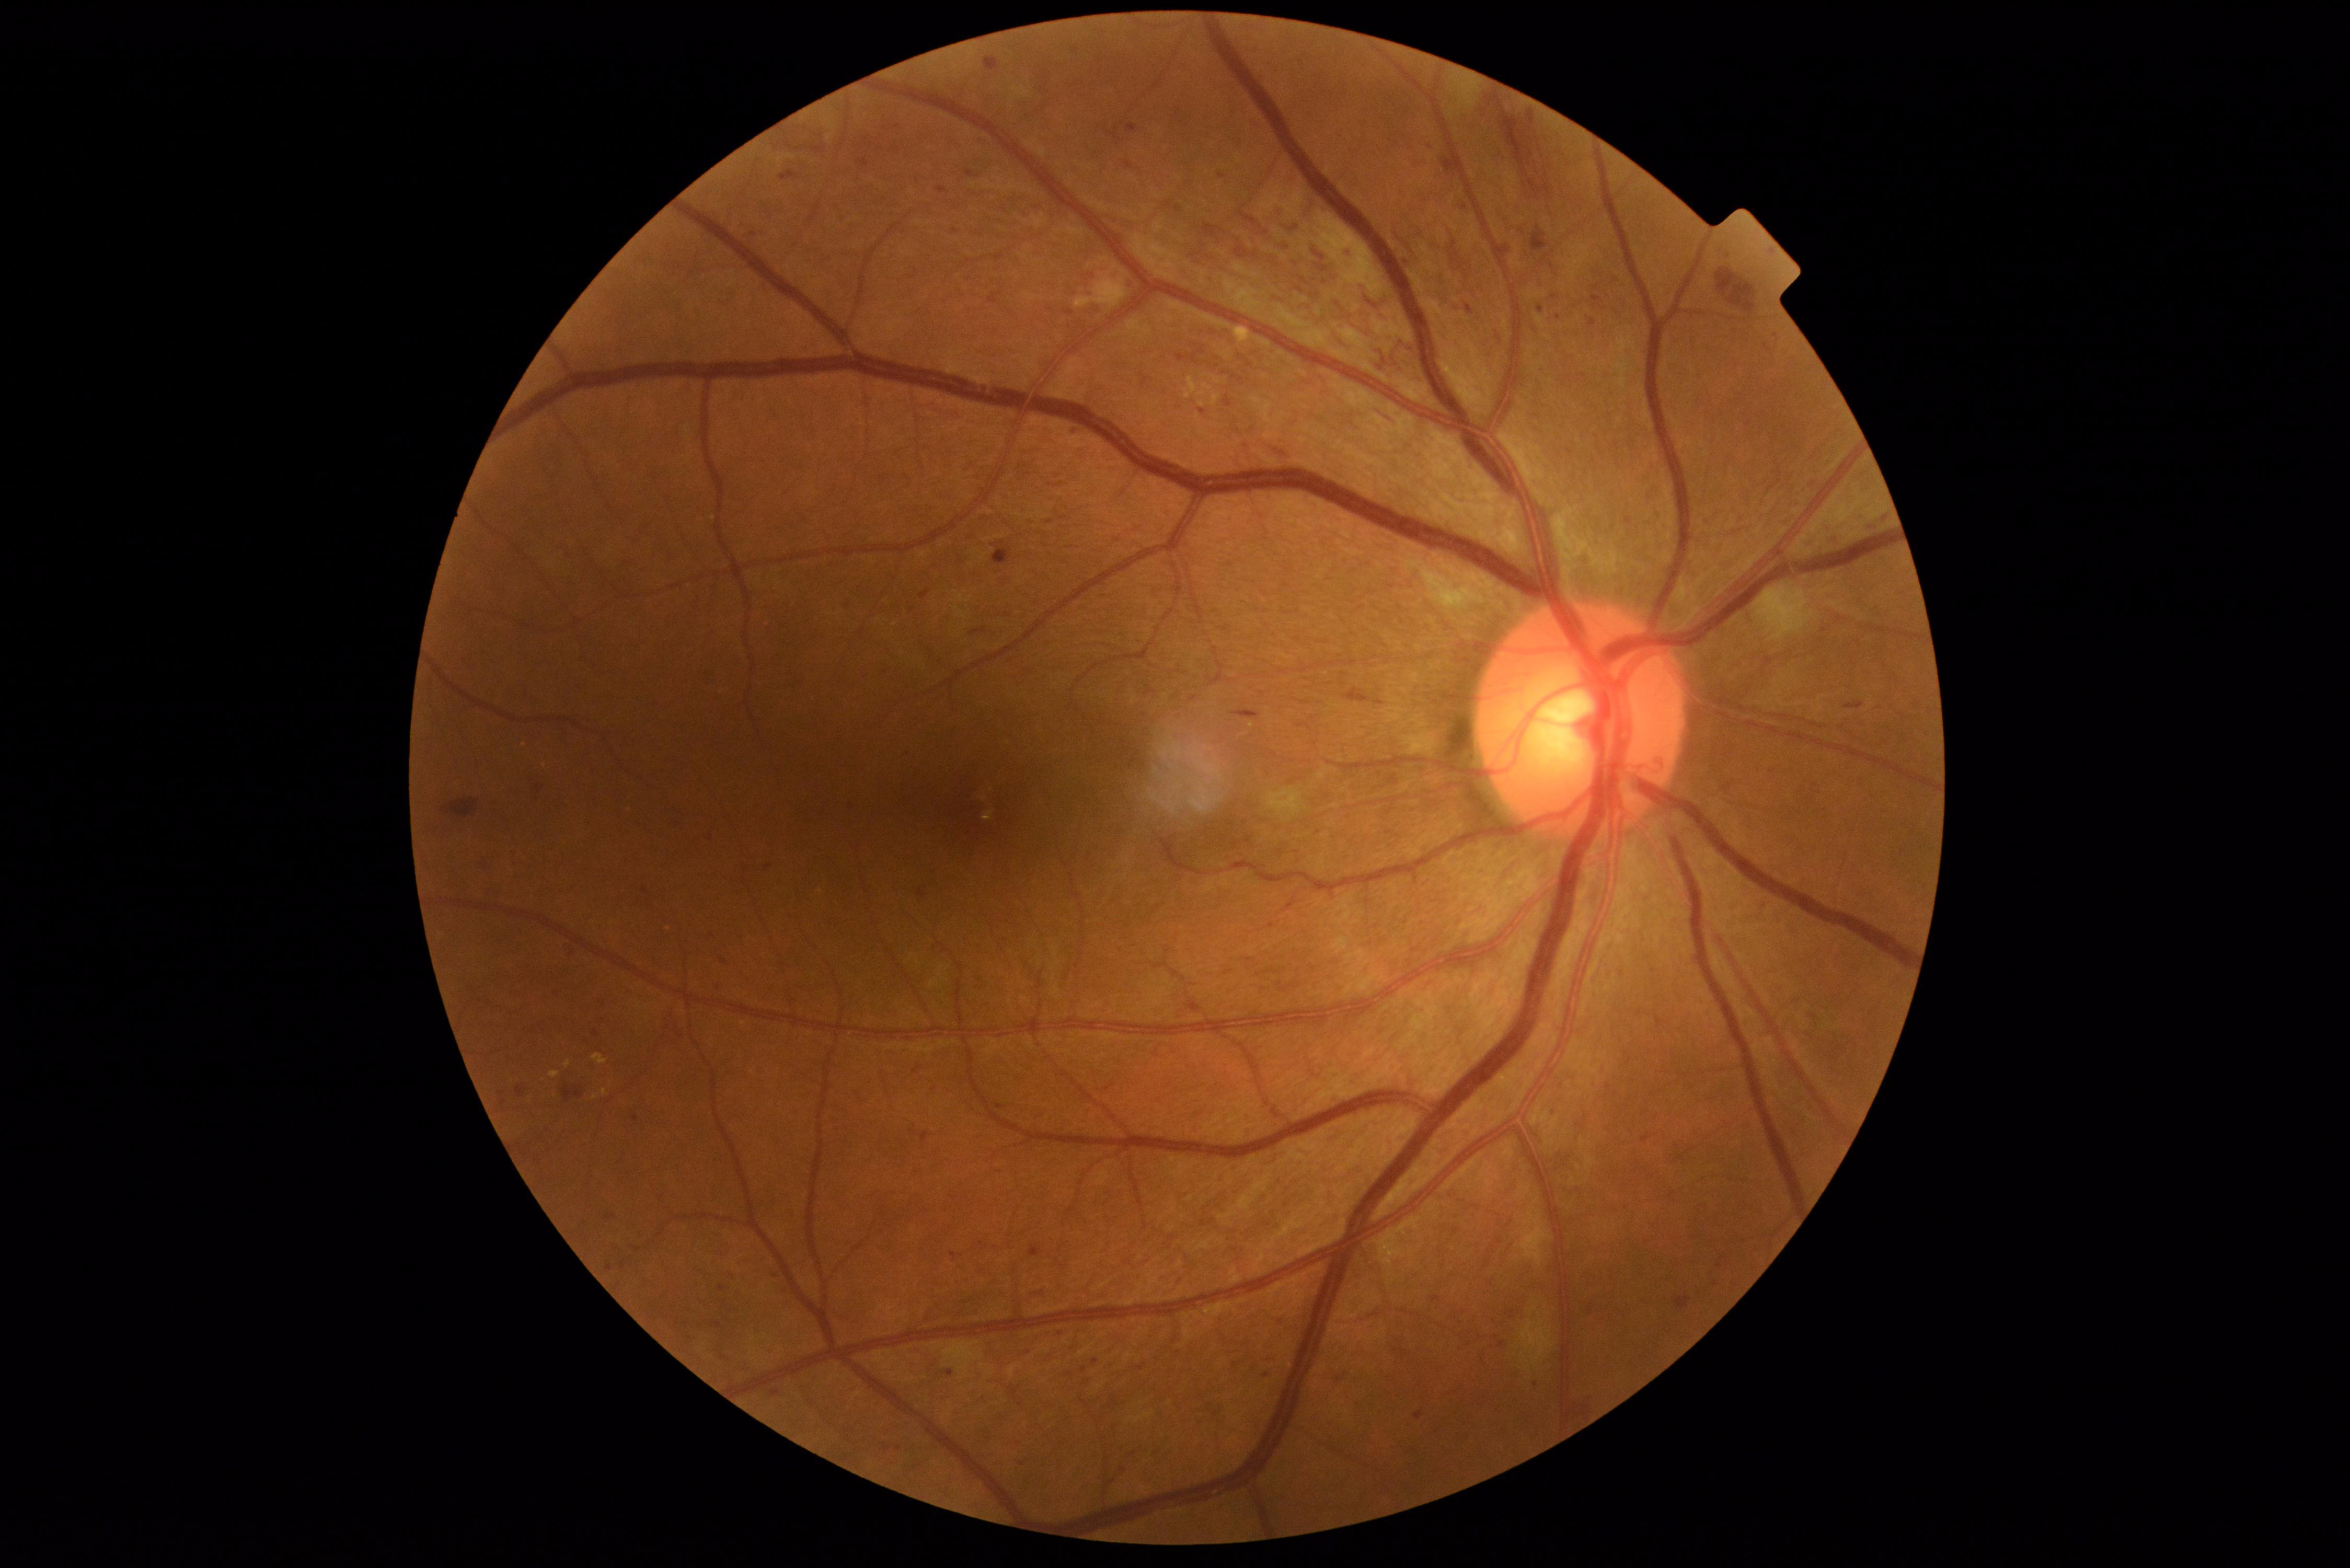
DR is 3.